Acquired on the Phoenix ICON · pediatric retinal photograph (wide-field) · 1240x1240
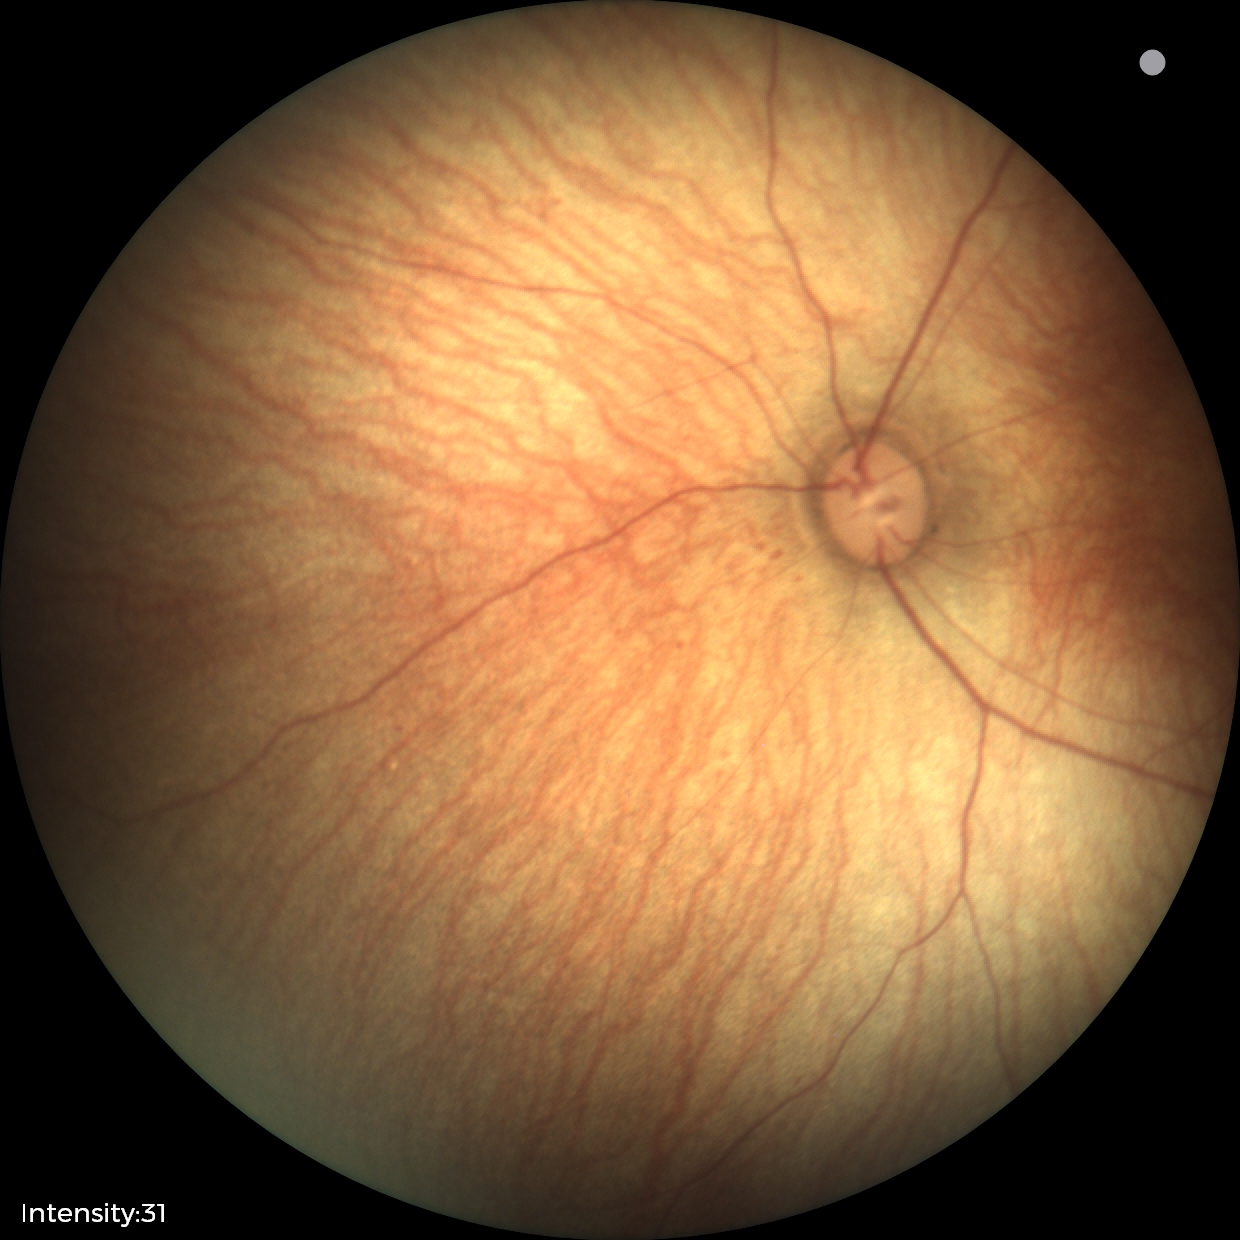 Examination with physiological retinal findings.